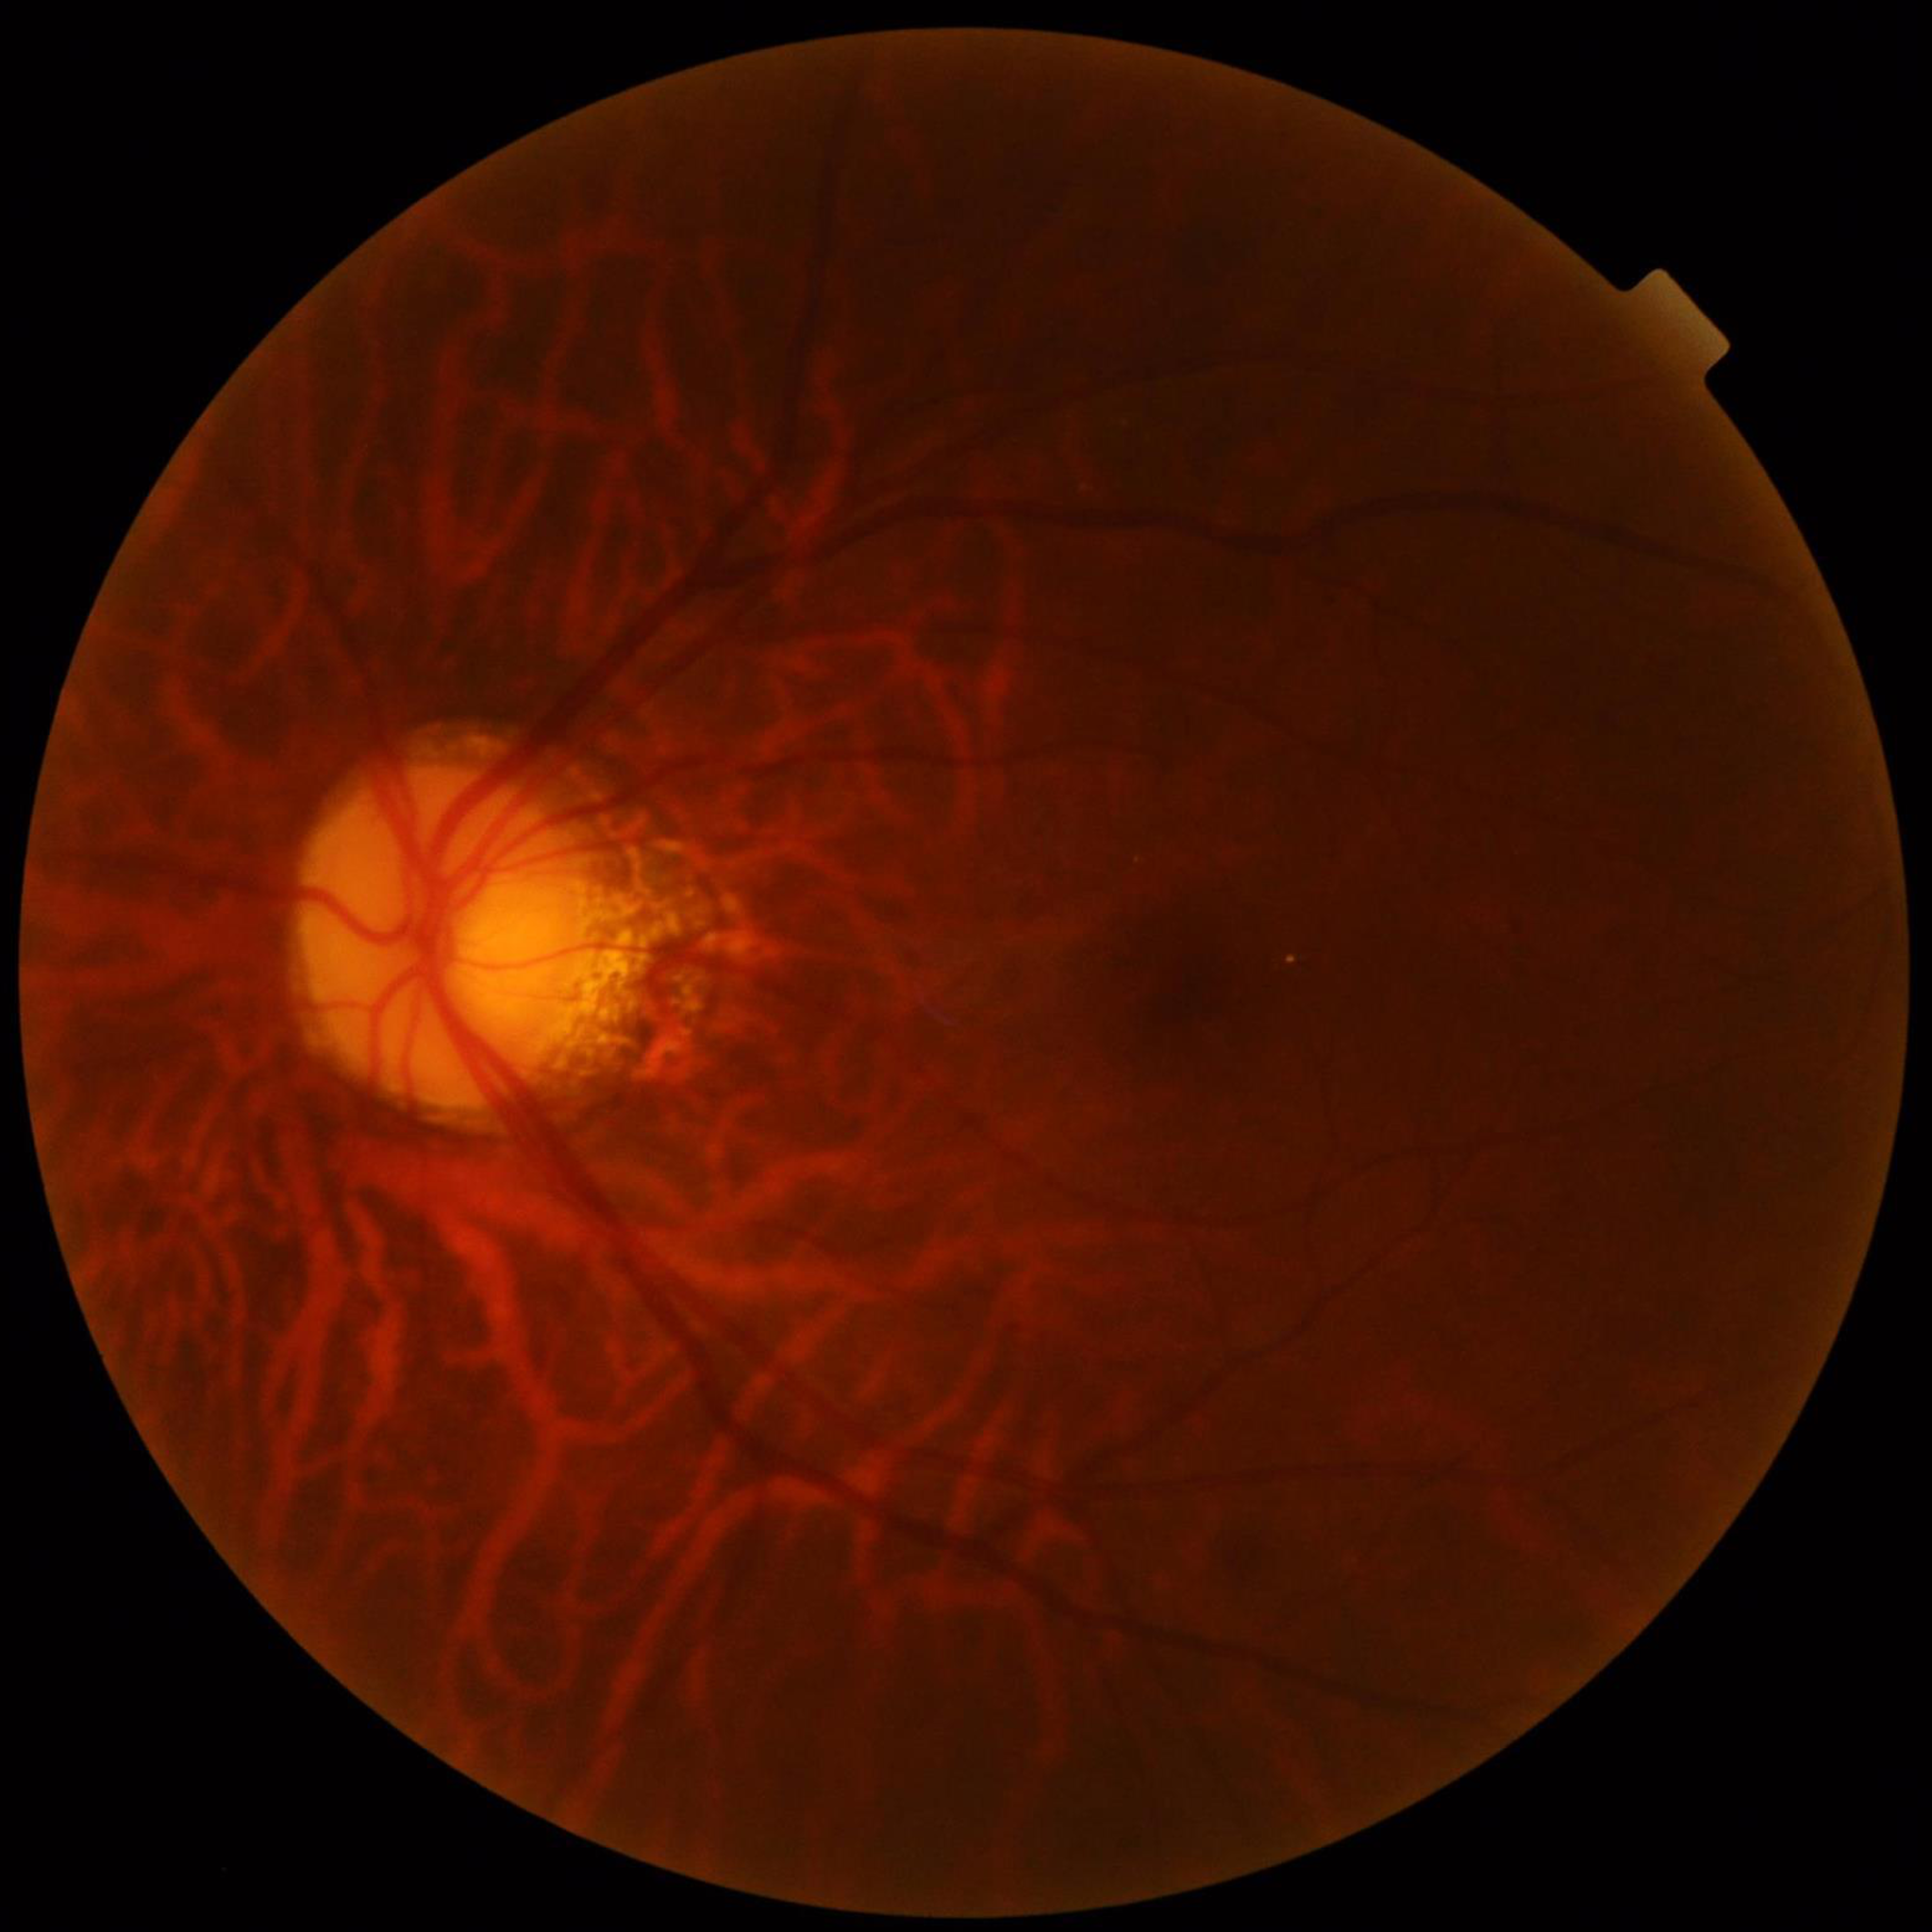 Clinical diagnosis: DR | Quality assessment: concerns include blur, illumination/color distortion.